640x480 · RetCam wide-field infant fundus image — 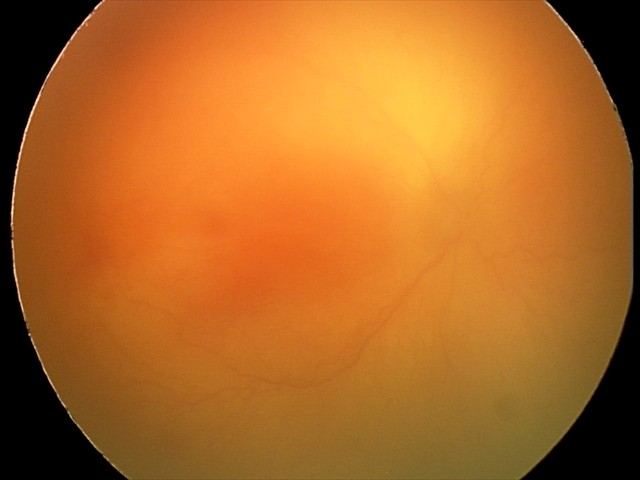

Diagnosis: aggressive retinopathy of prematurity (A-ROP), plus disease: present.